Modified Davis classification: 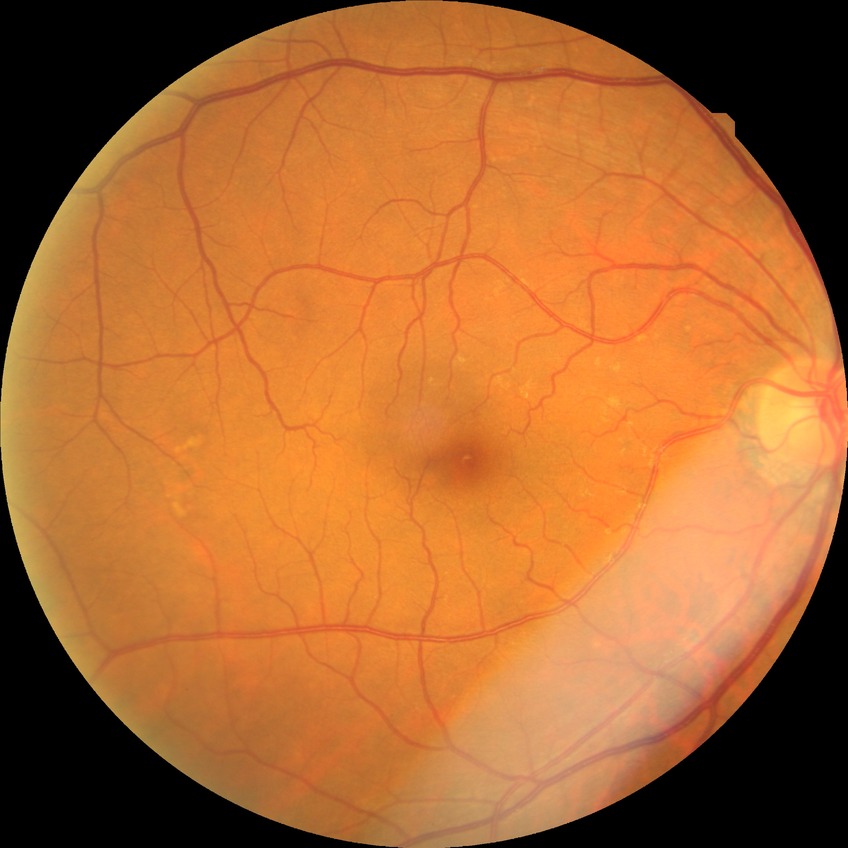 Diabetic retinopathy severity: no diabetic retinopathy.